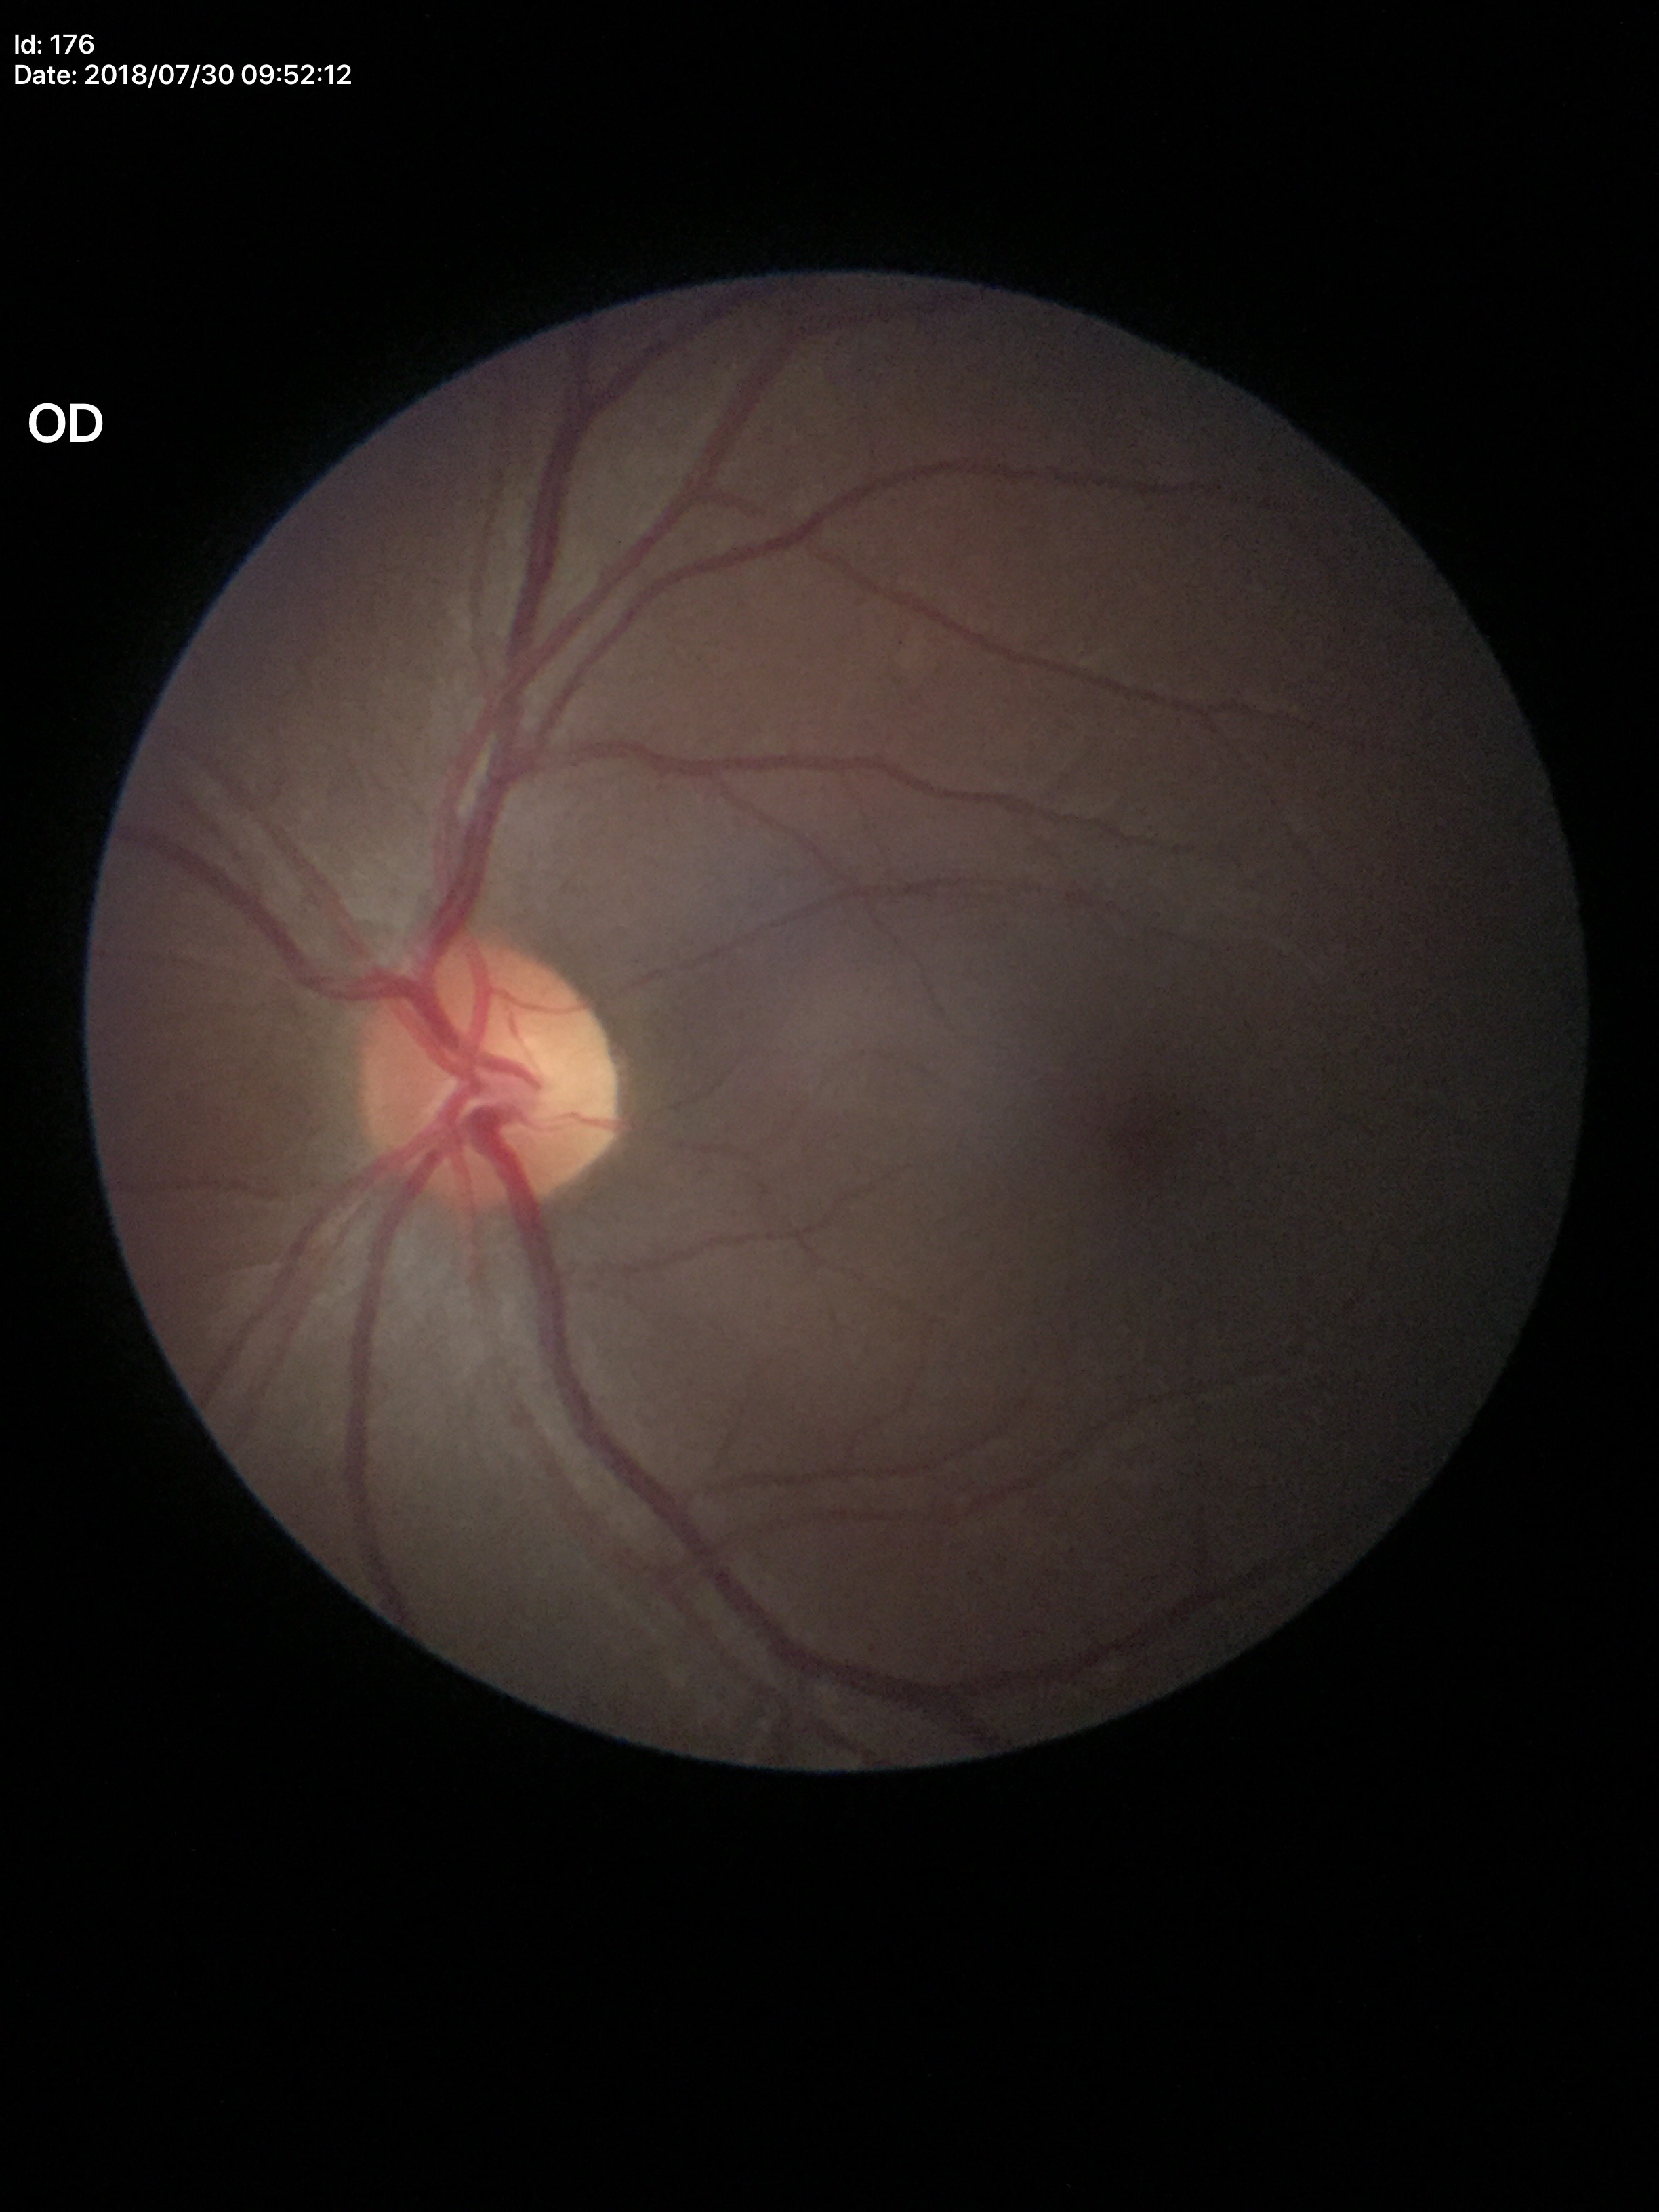 vertical CDR = 0.46
horizontal CDR = 0.50
Glaucoma impression = negative (5/5 ophthalmologists in agreement)